Infant wide-field retinal image · 640 by 480 pixels
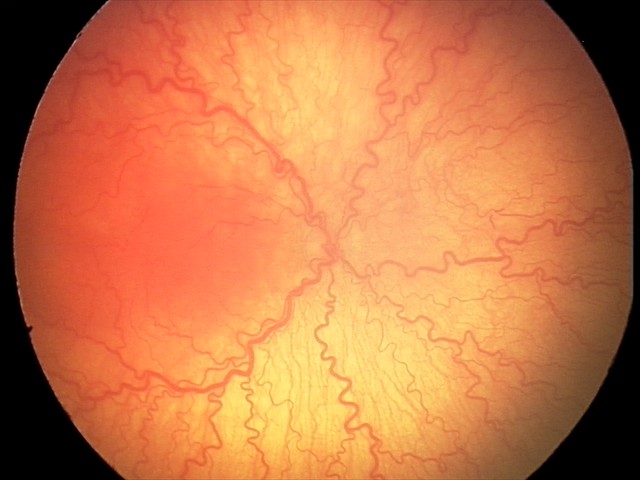 Examination diagnosed as aggressive retinopathy of prematurity (A-ROP).
With plus disease.